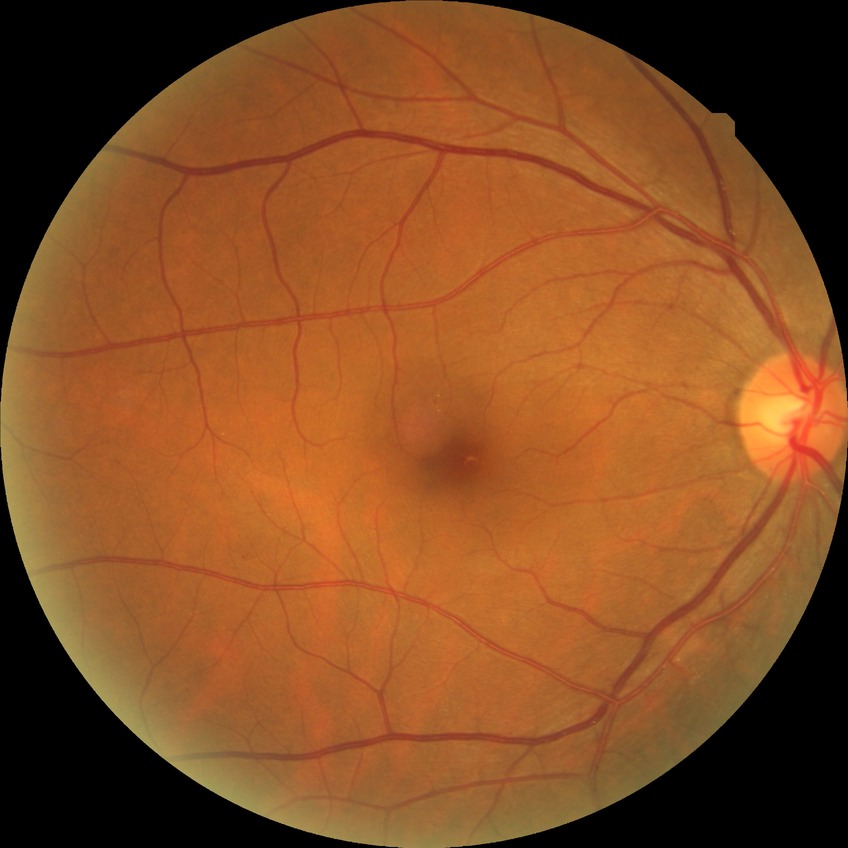
Diabetic retinopathy (DR): SDR (simple diabetic retinopathy).